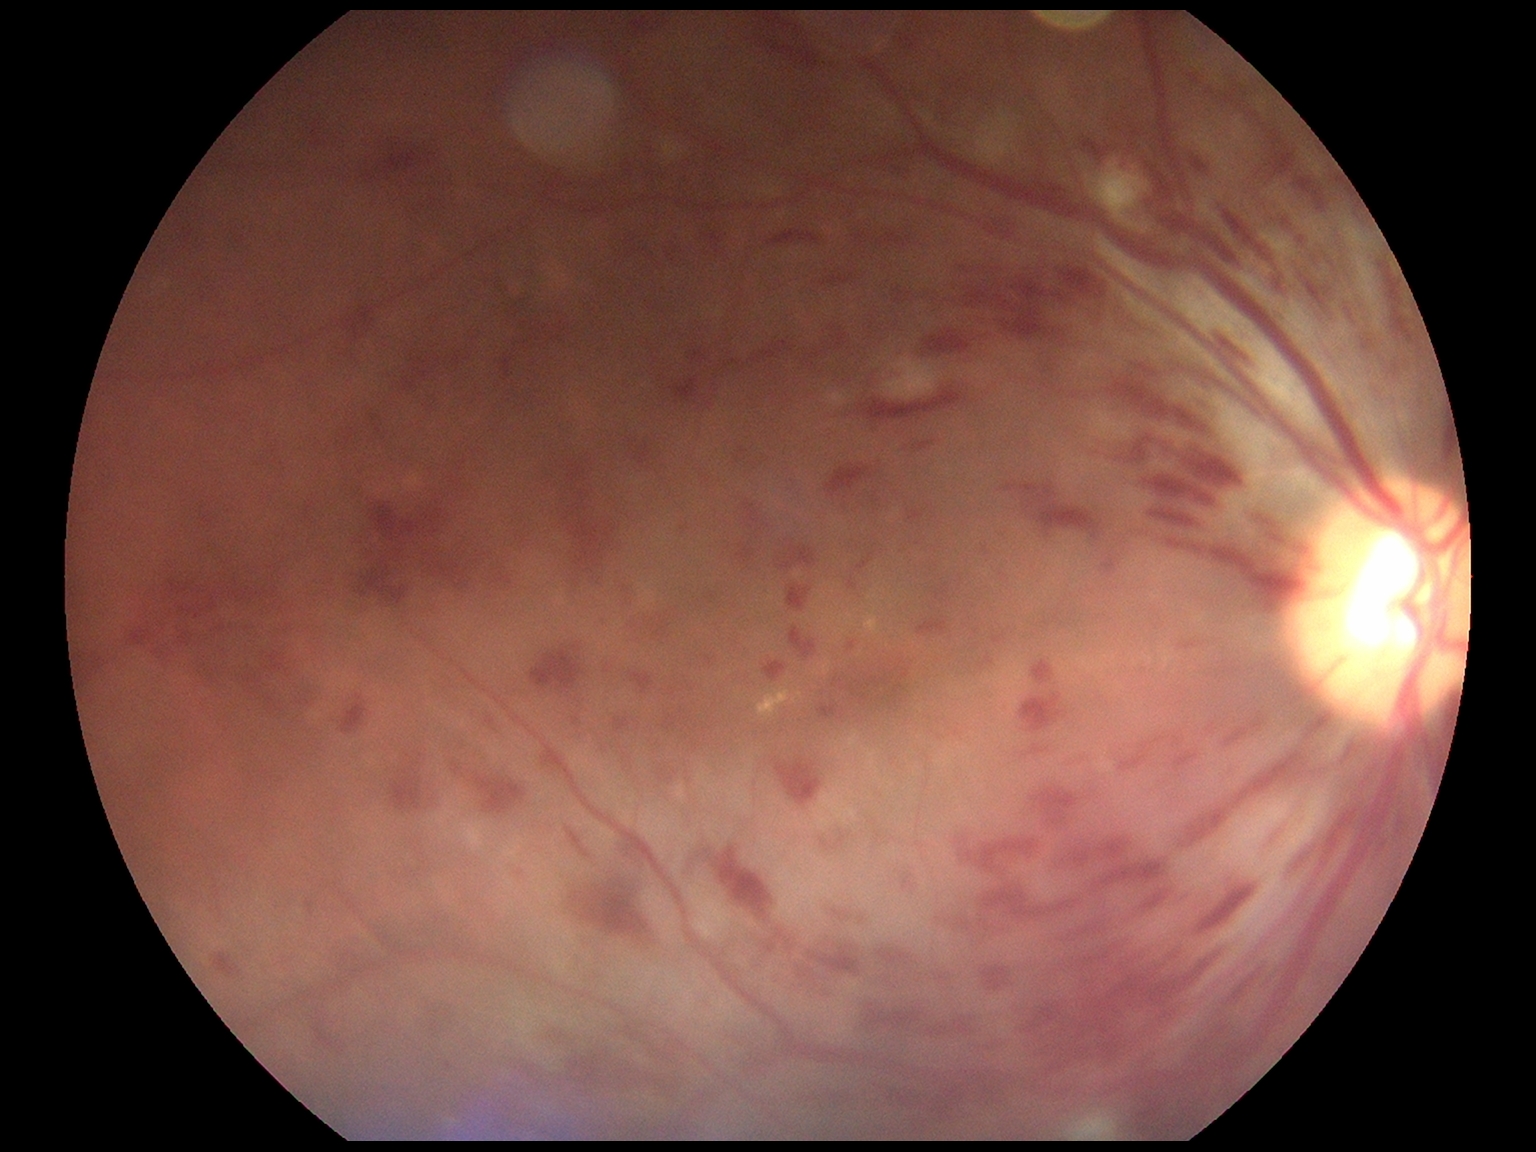
DR severity: 3.